Nonmydriatic fundus photograph, modified Davis classification, camera: NIDEK AFC-230
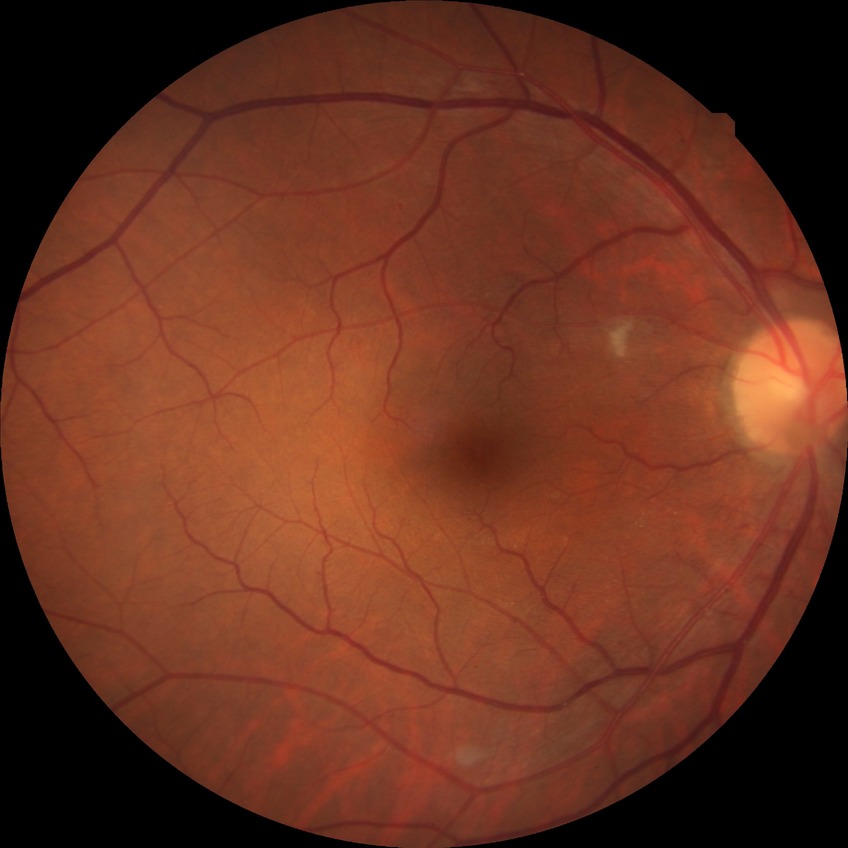 Diabetic retinopathy (DR): NDR (no diabetic retinopathy).